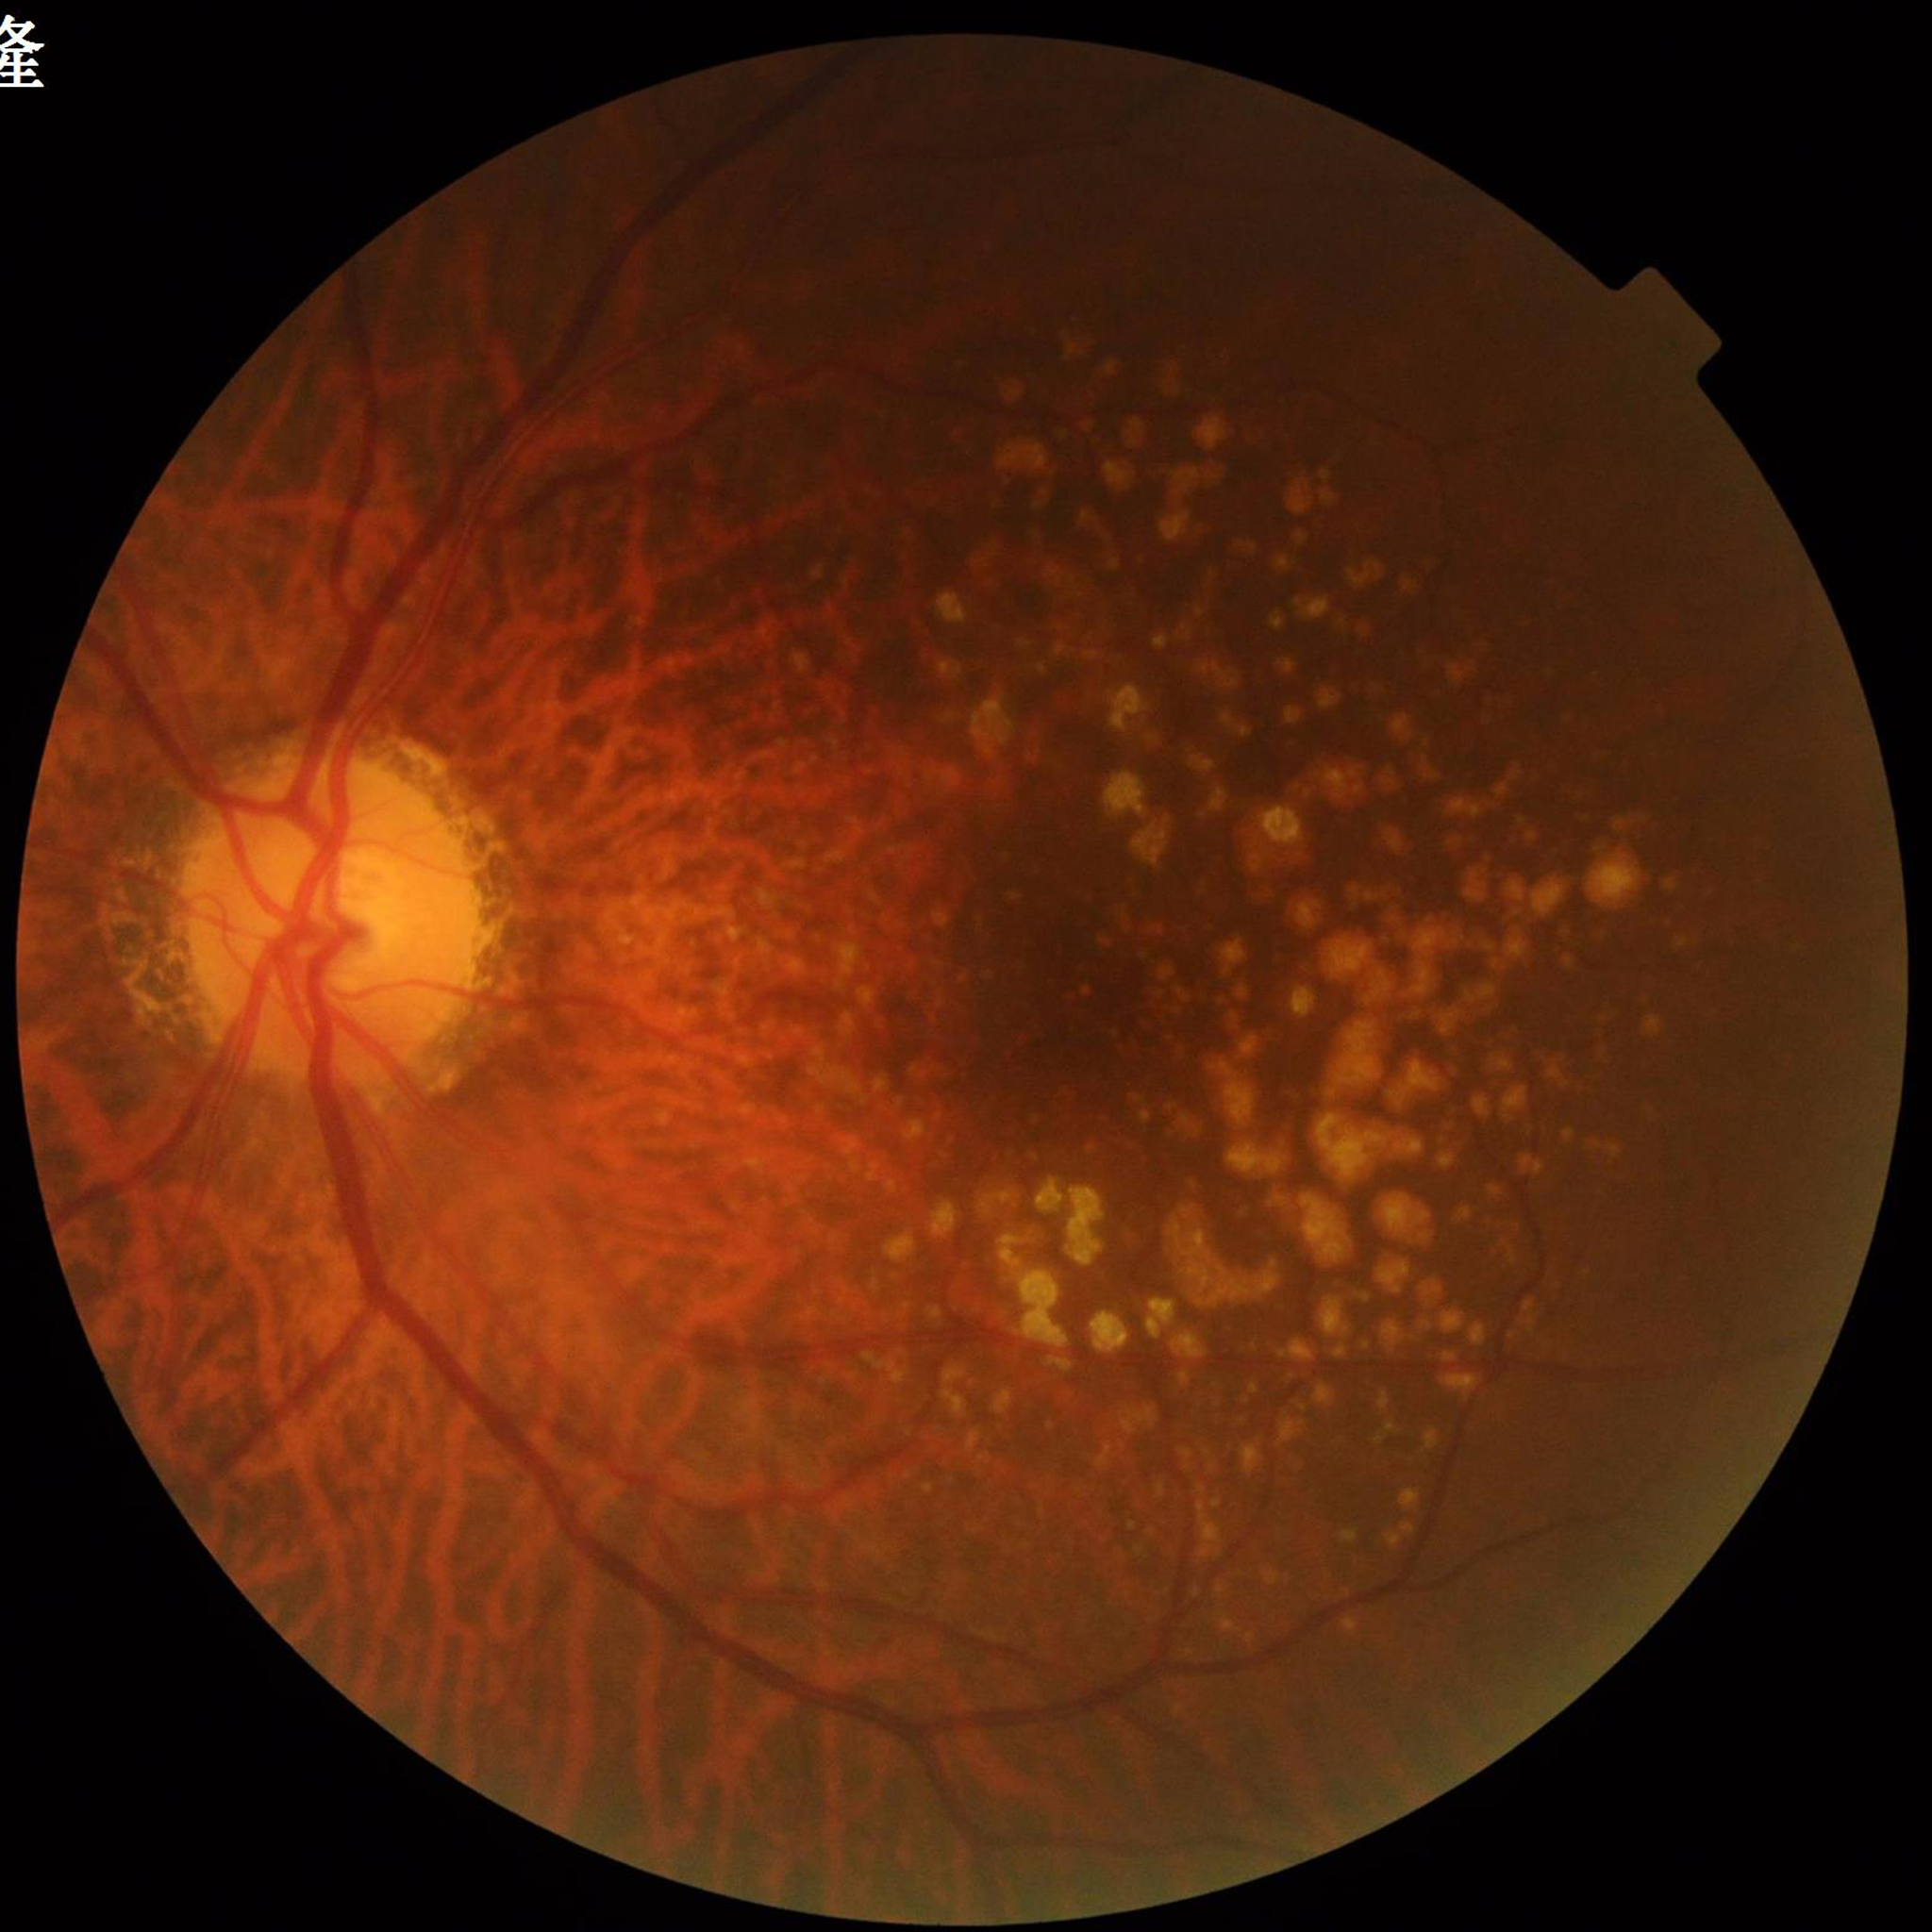

Fundus image of an eye with AMD.